Image size 848x848, 45 degree fundus photograph, camera: NIDEK AFC-230, nonmydriatic fundus photograph — 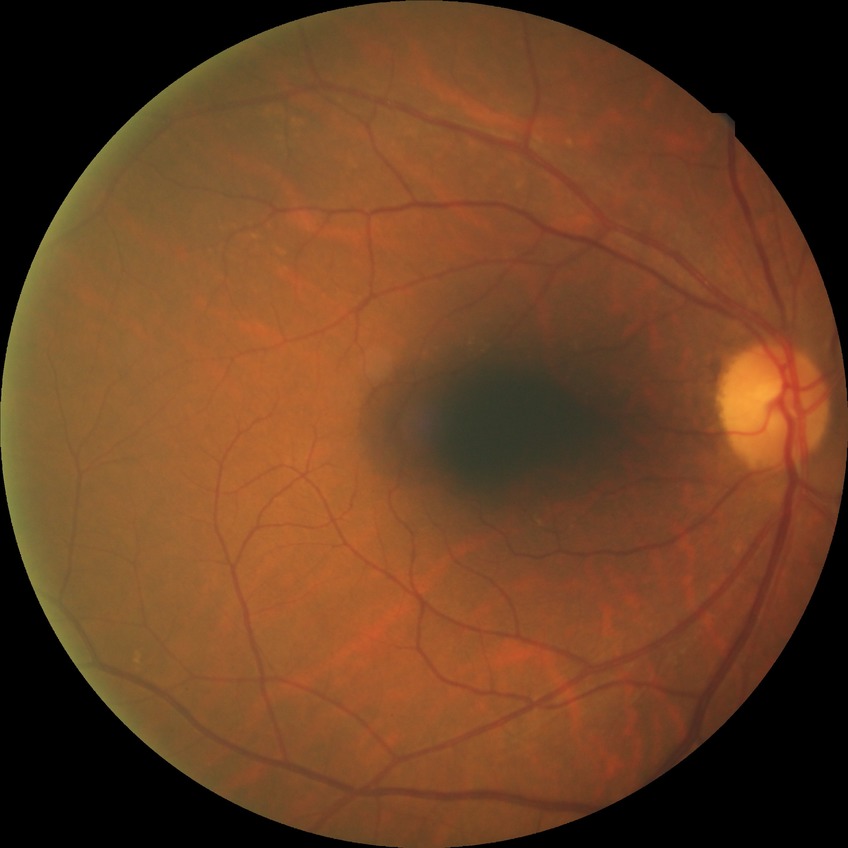

Diabetic retinopathy (DR) is NDR (no diabetic retinopathy).